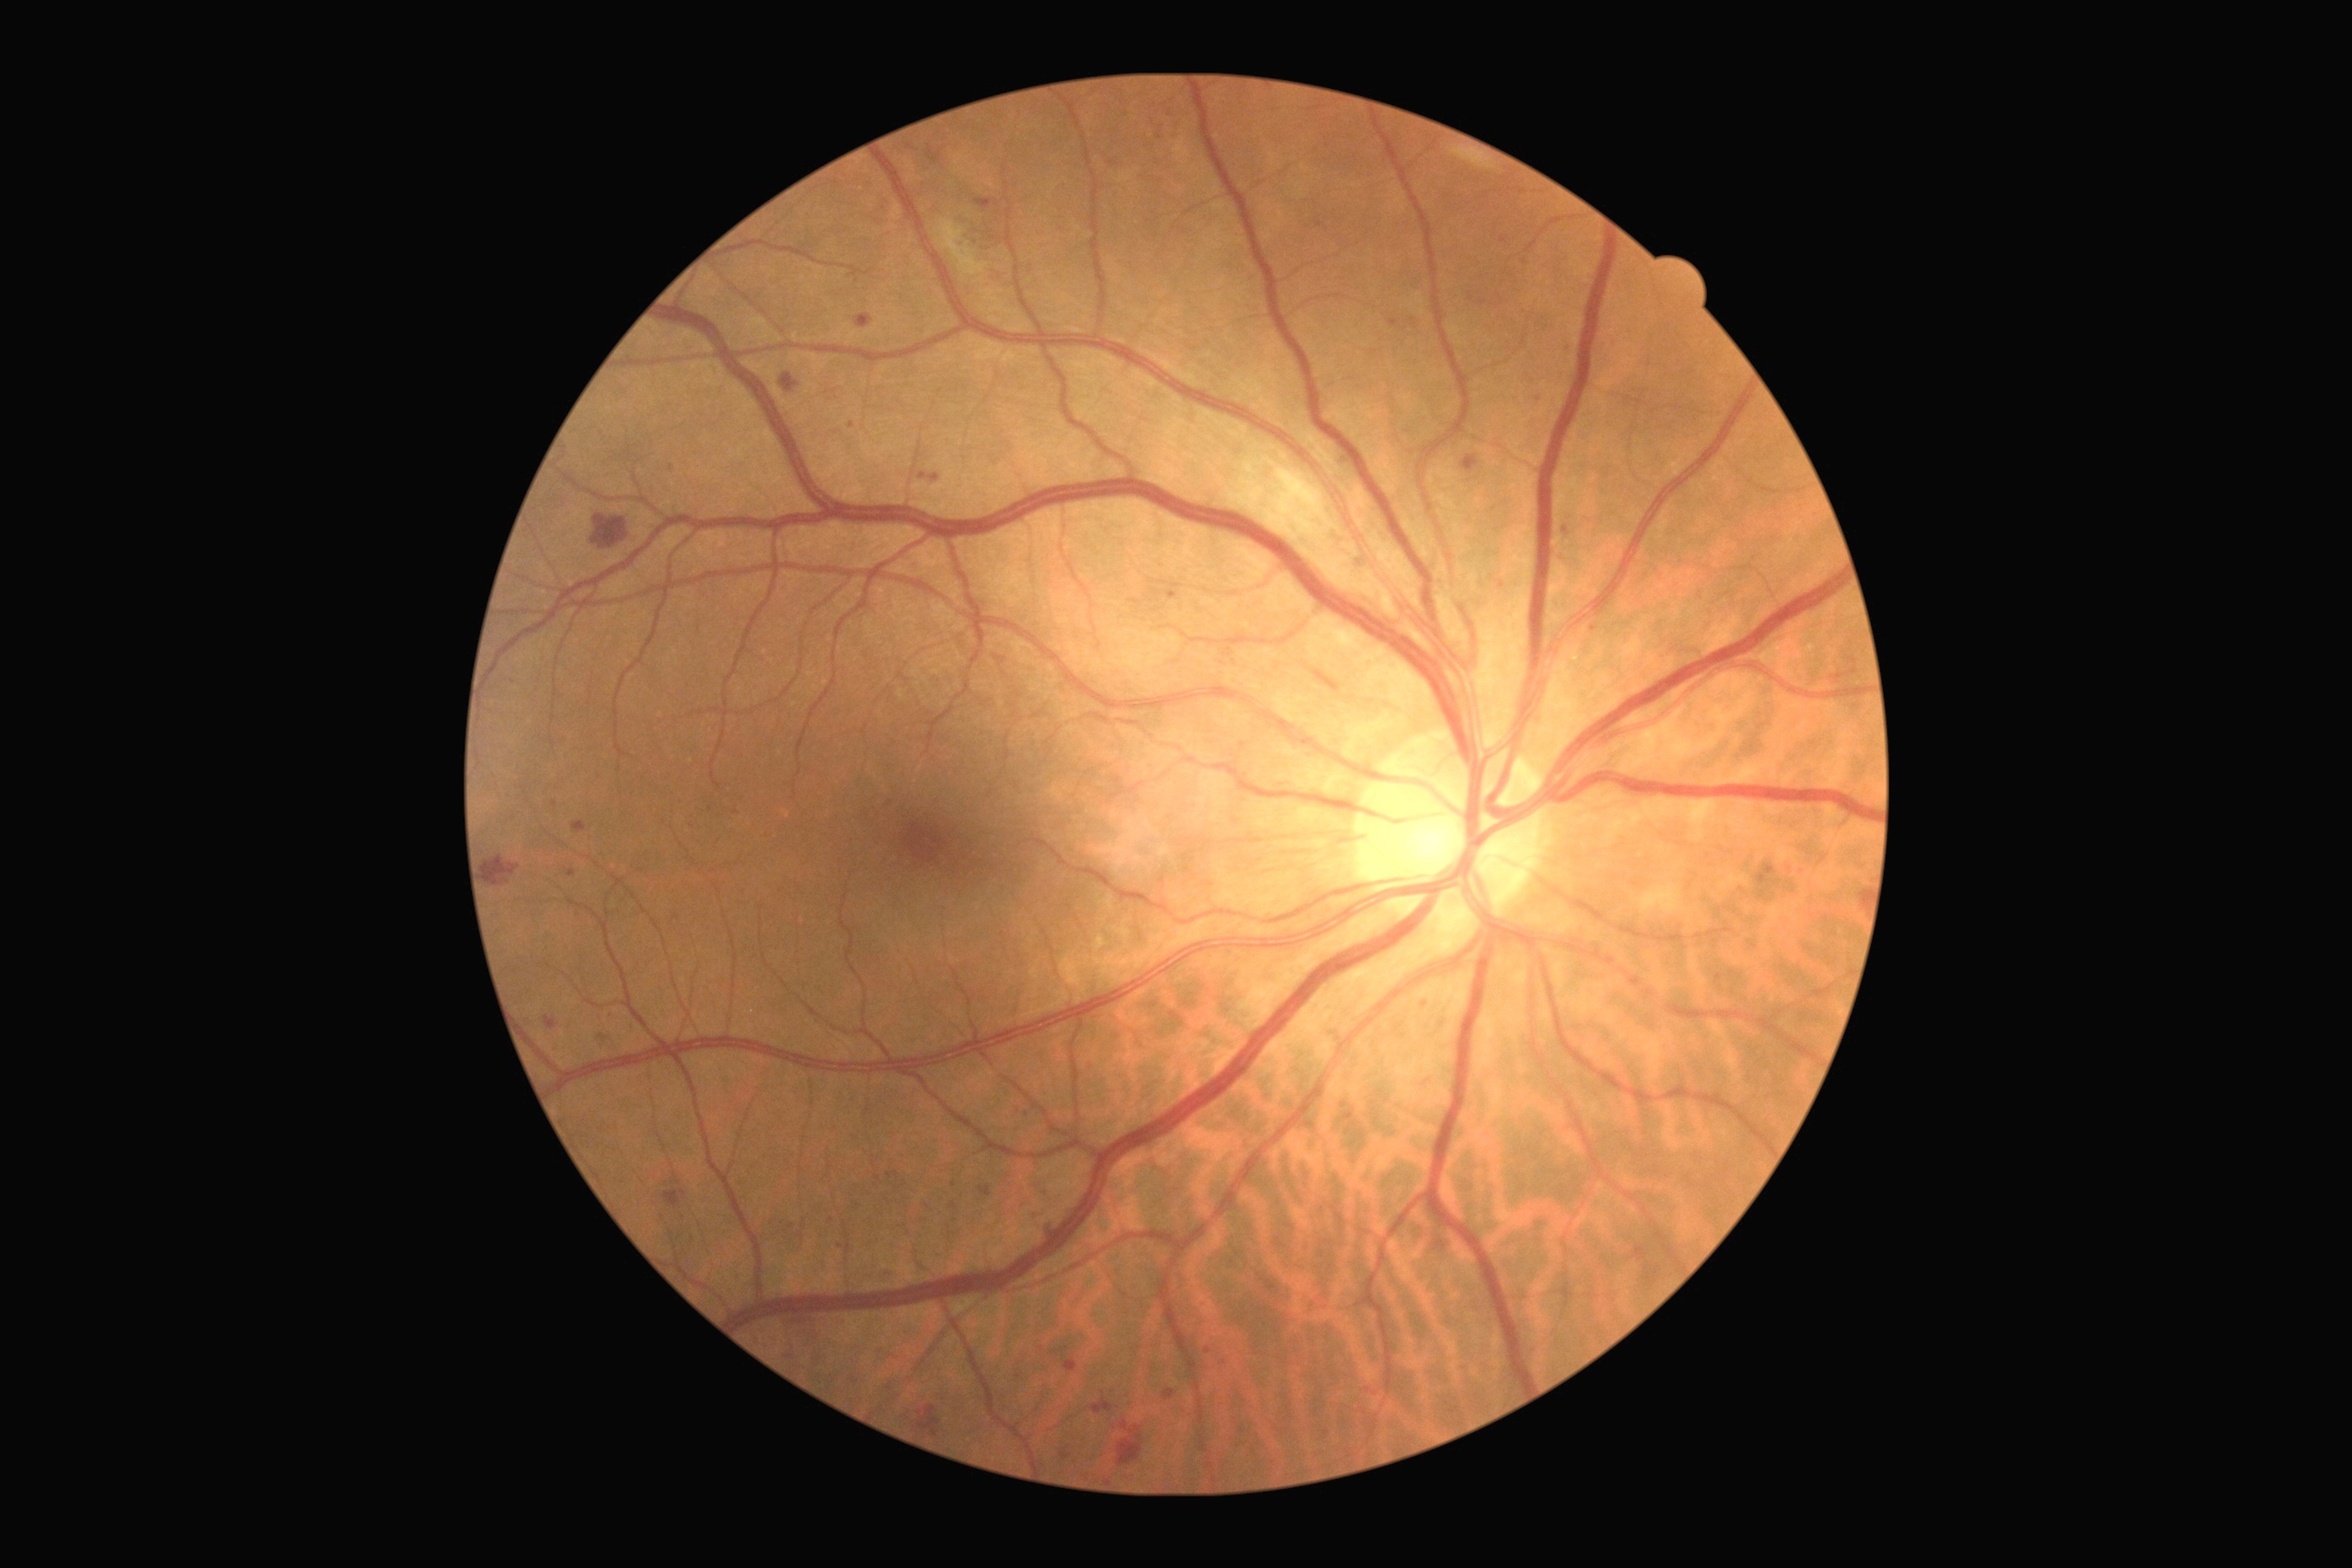
retinopathy = 2
DR class = non-proliferative diabetic retinopathy